Remidio Fundus on Phone (FOP) camera; fundus photo
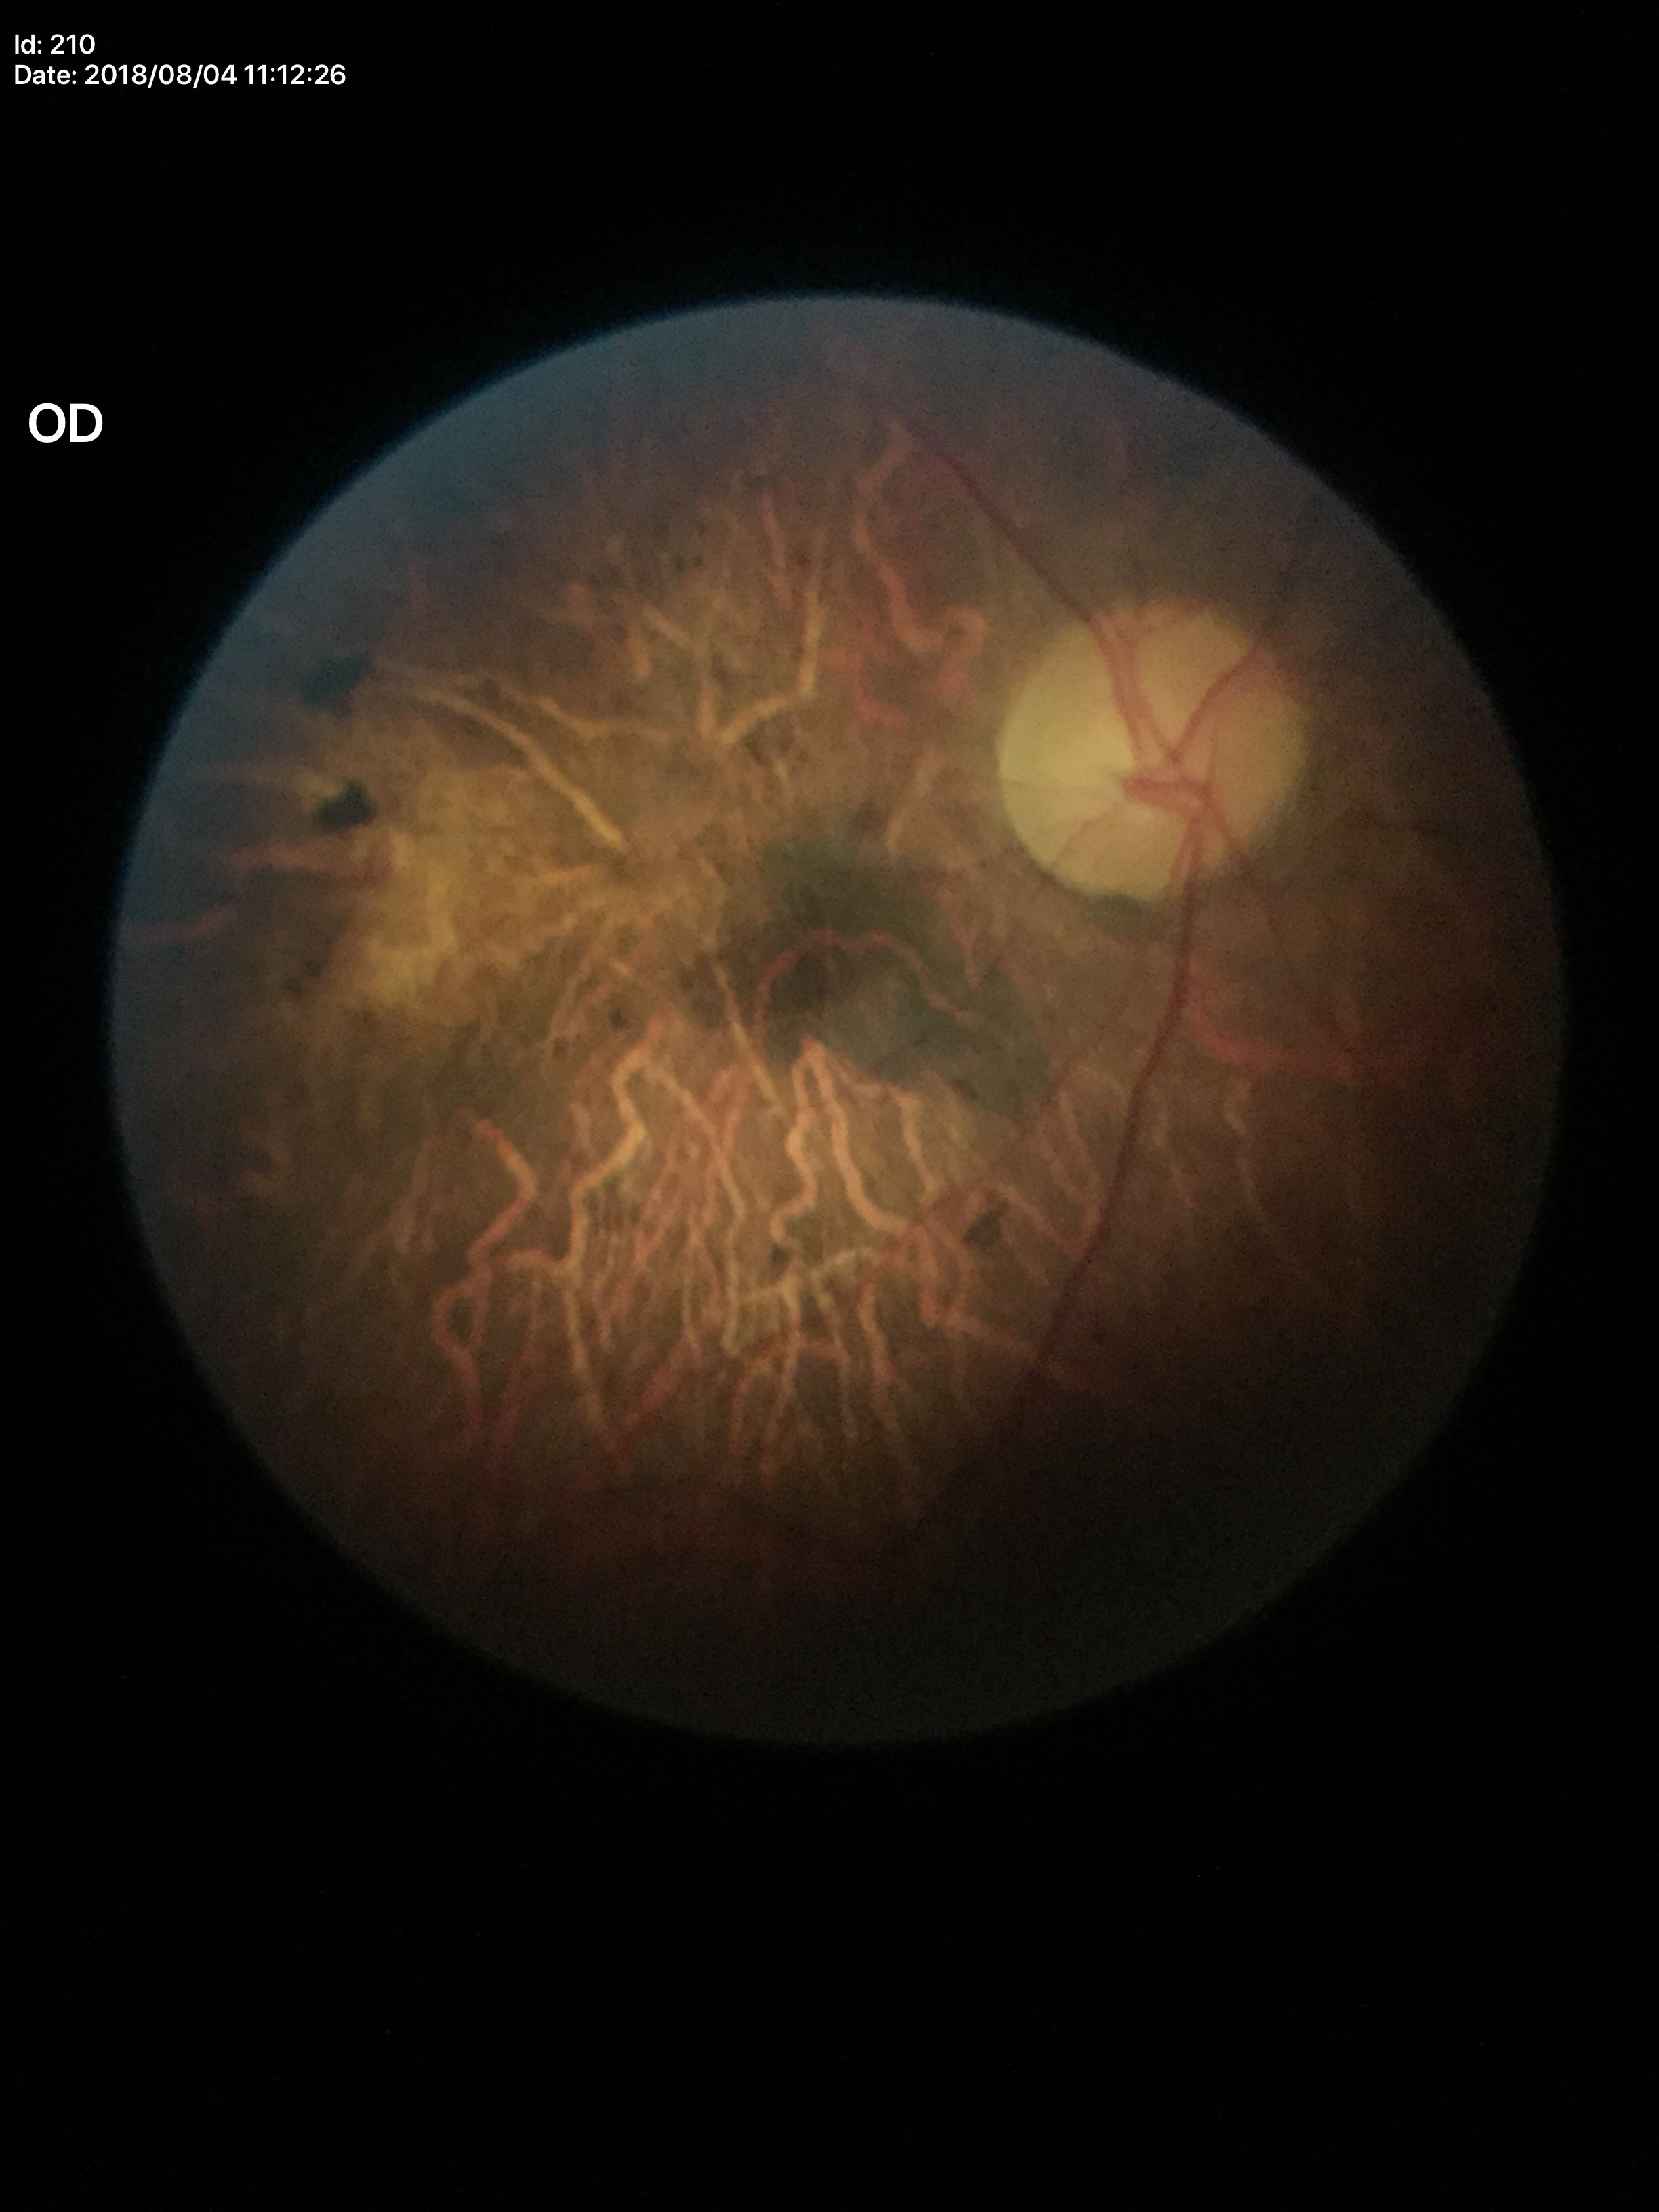

Q: Is there glaucoma suspicion?
A: not suspect
Q: Vertical CDR?
A: 0.50
Q: Horizontal CDR?
A: 0.52